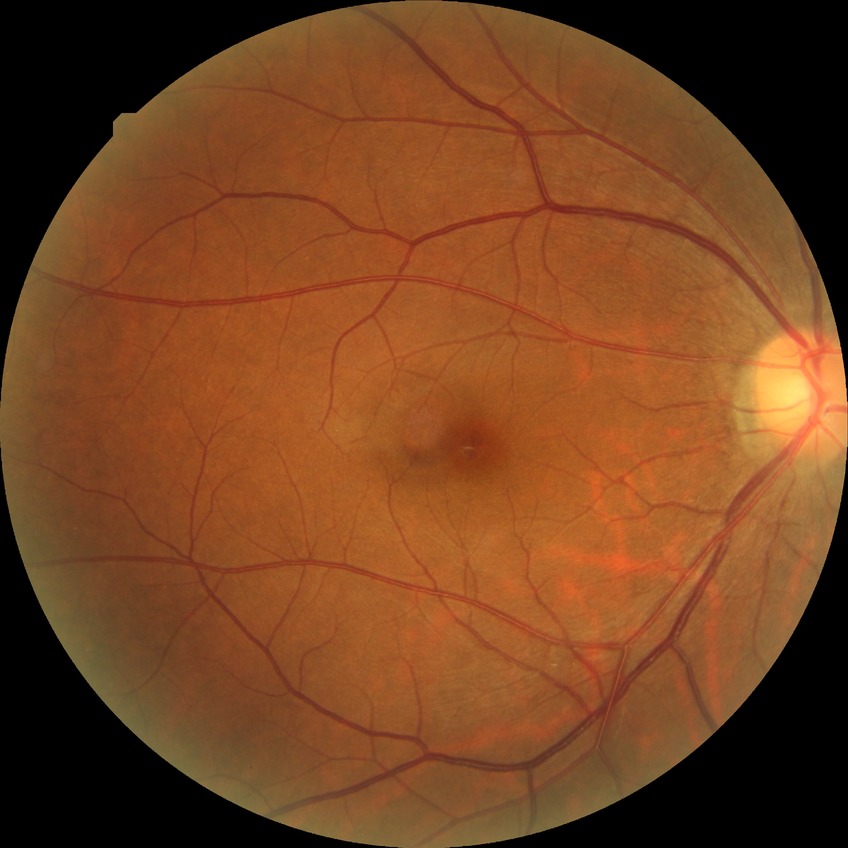

Assessment:
* retinopathy stage — no diabetic retinopathy